Image size 2352x1568 — 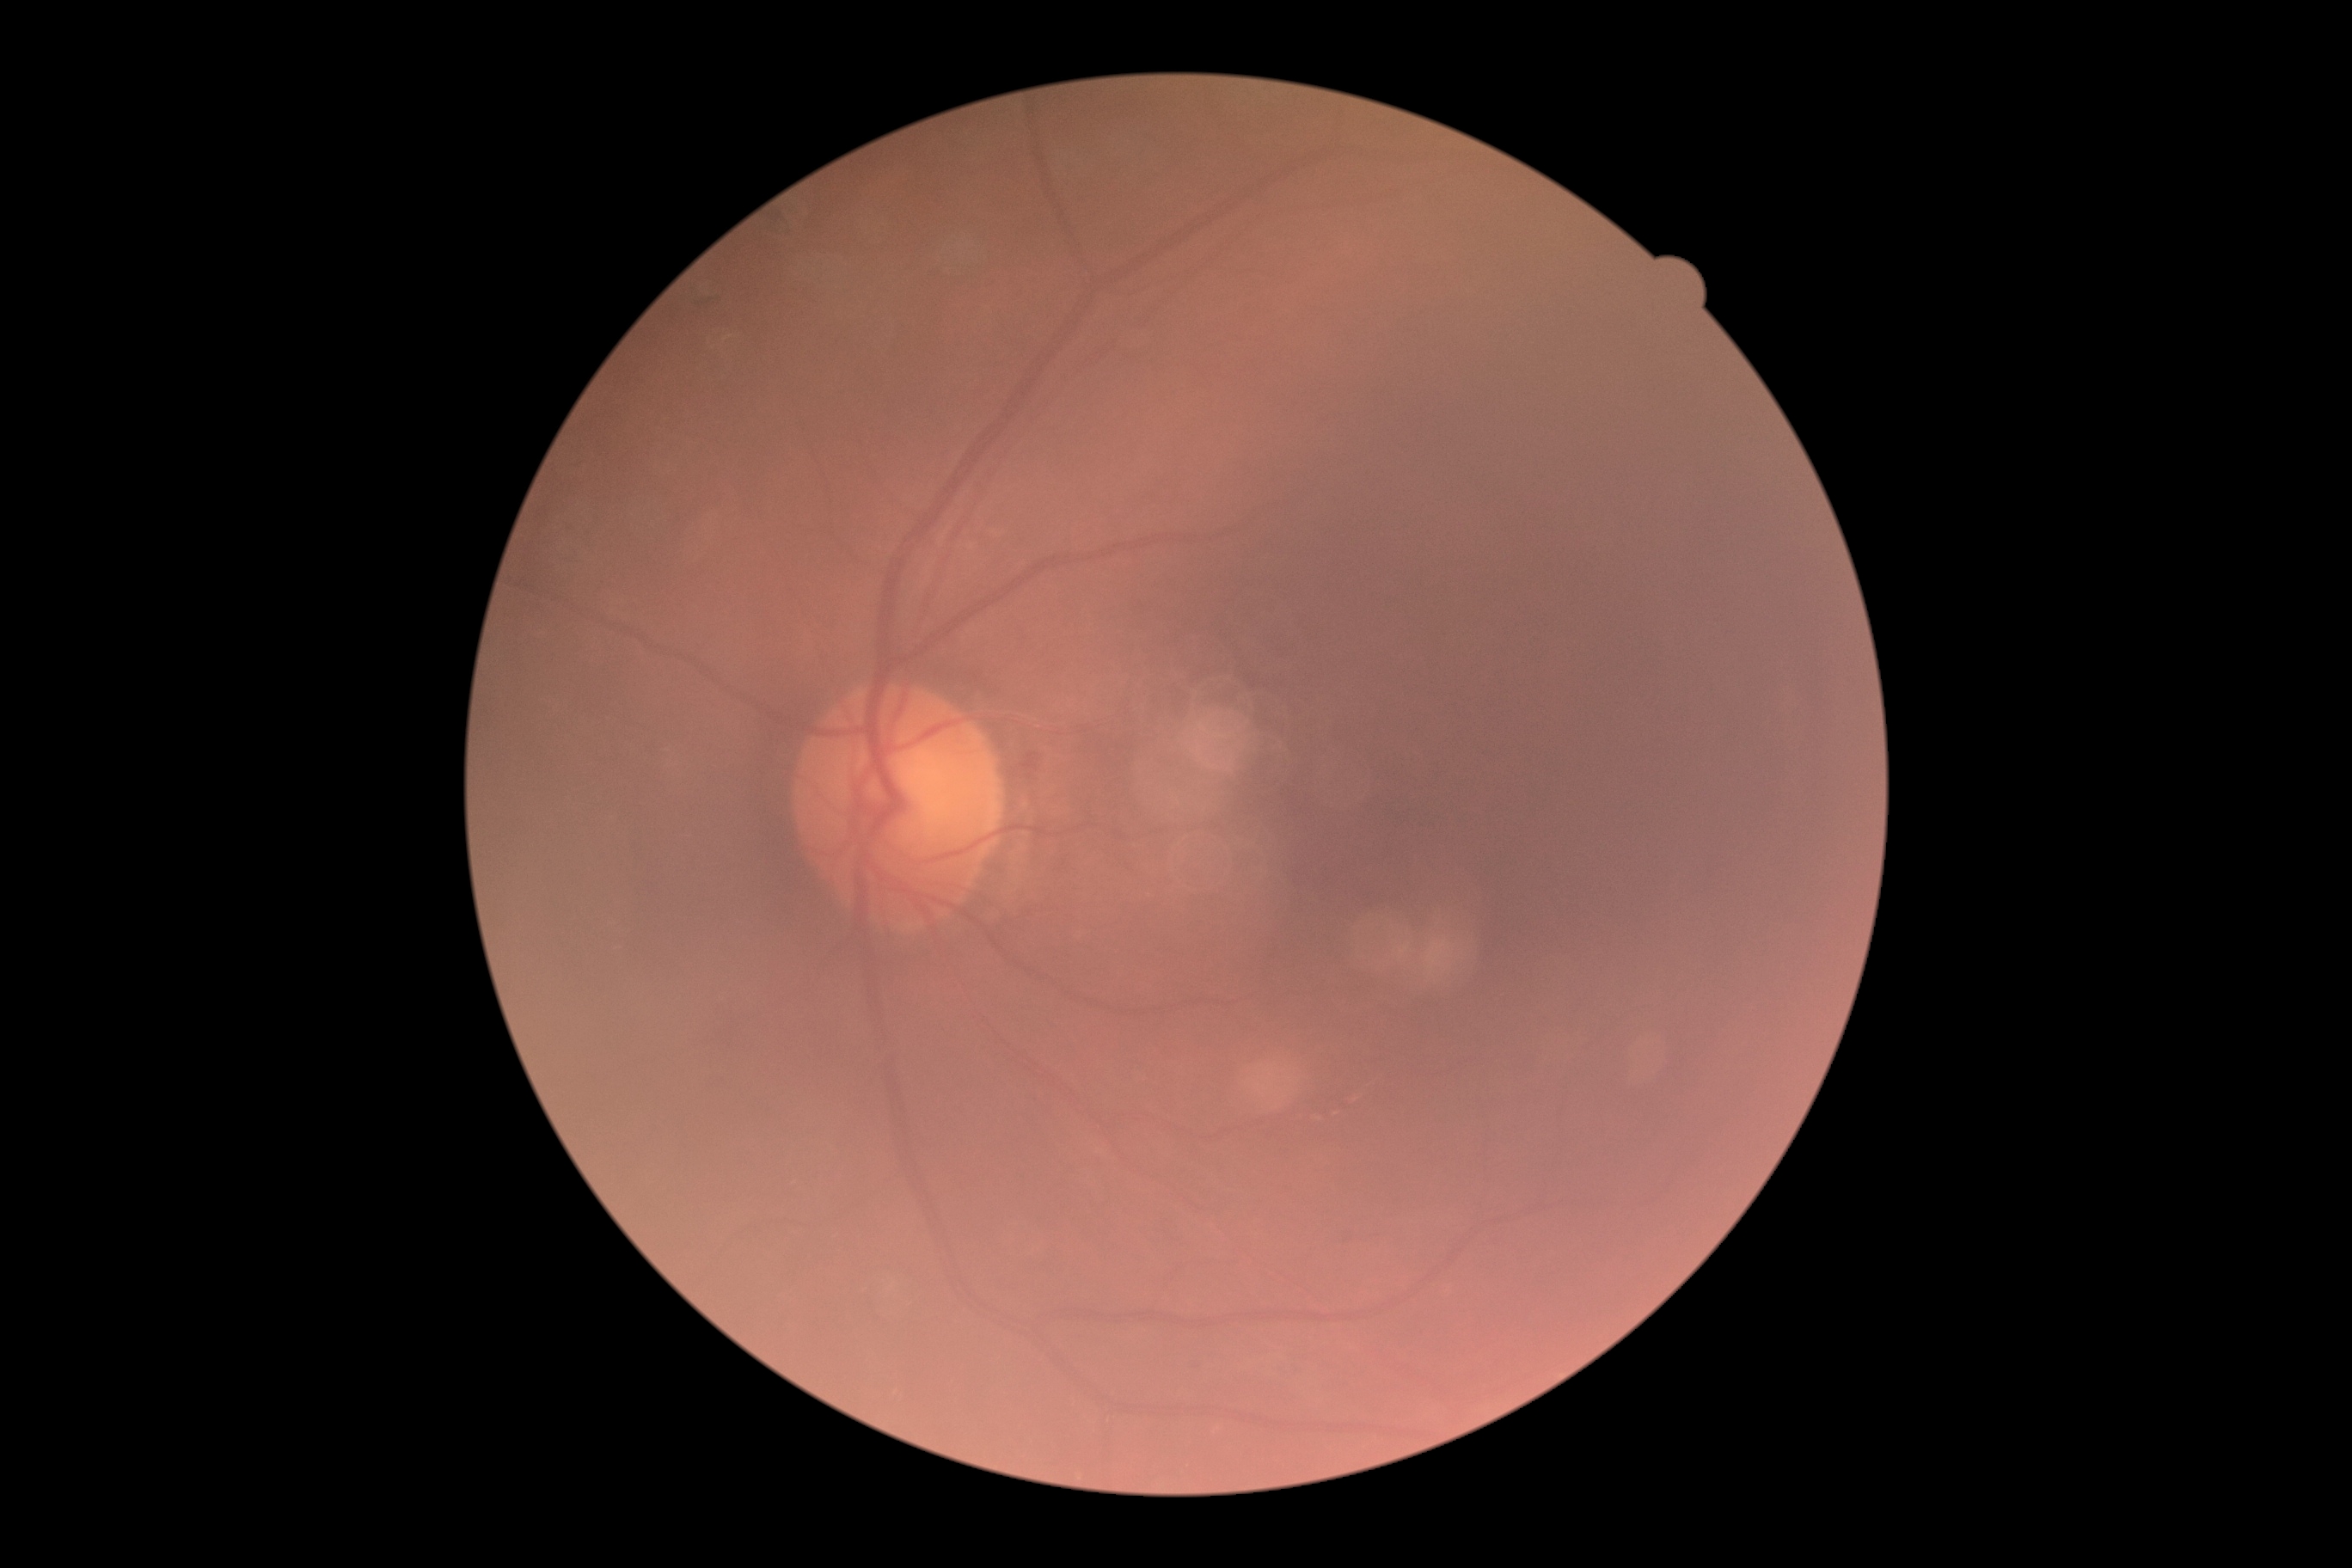

- diabetic retinopathy (DR) — grade 2 (moderate NPDR)